Wide-field fundus photograph from neonatal ROP screening — 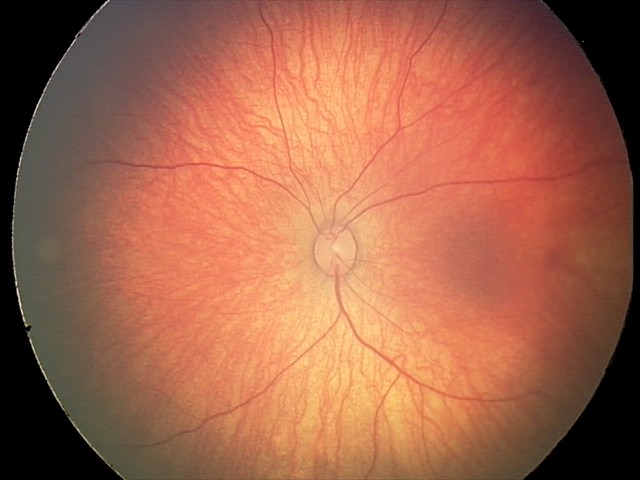

Screening series with retinal hemorrhages.